2361 by 1568 pixels; color fundus photograph; FOV: 50 degrees: 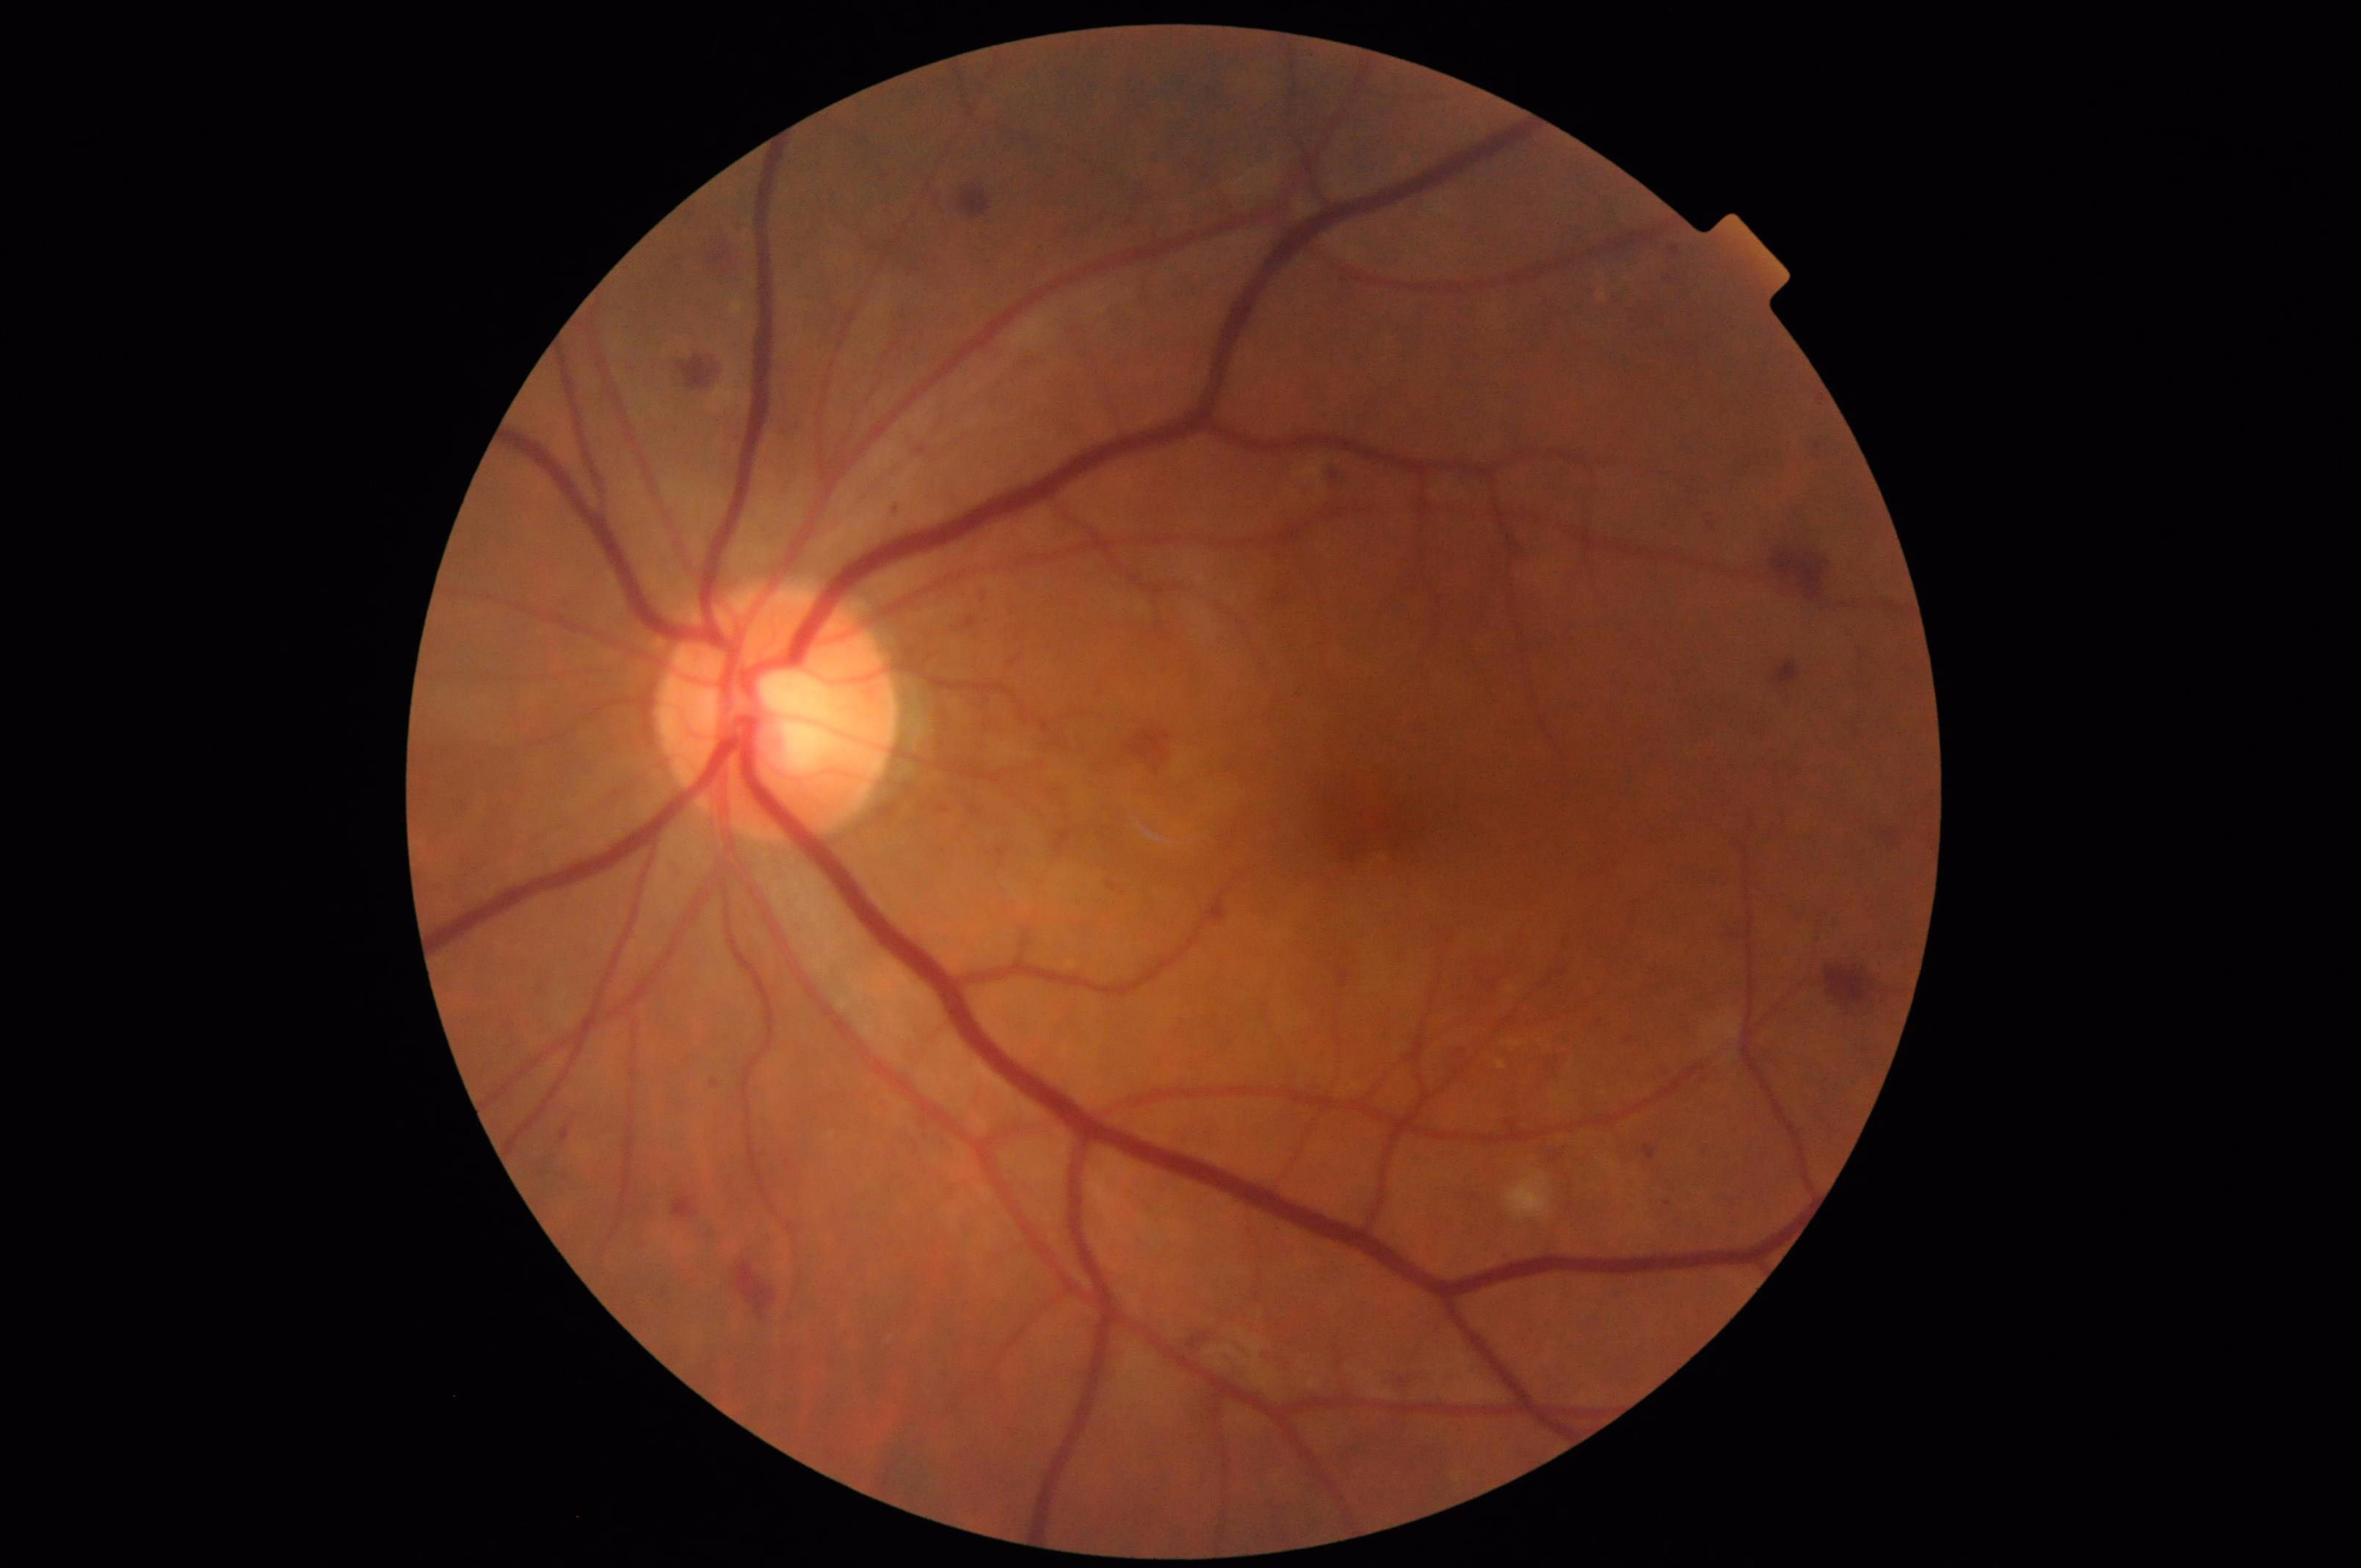

Overall image quality is good. Contrast is good. No over- or under-exposure. Image is sharp throughout the field.